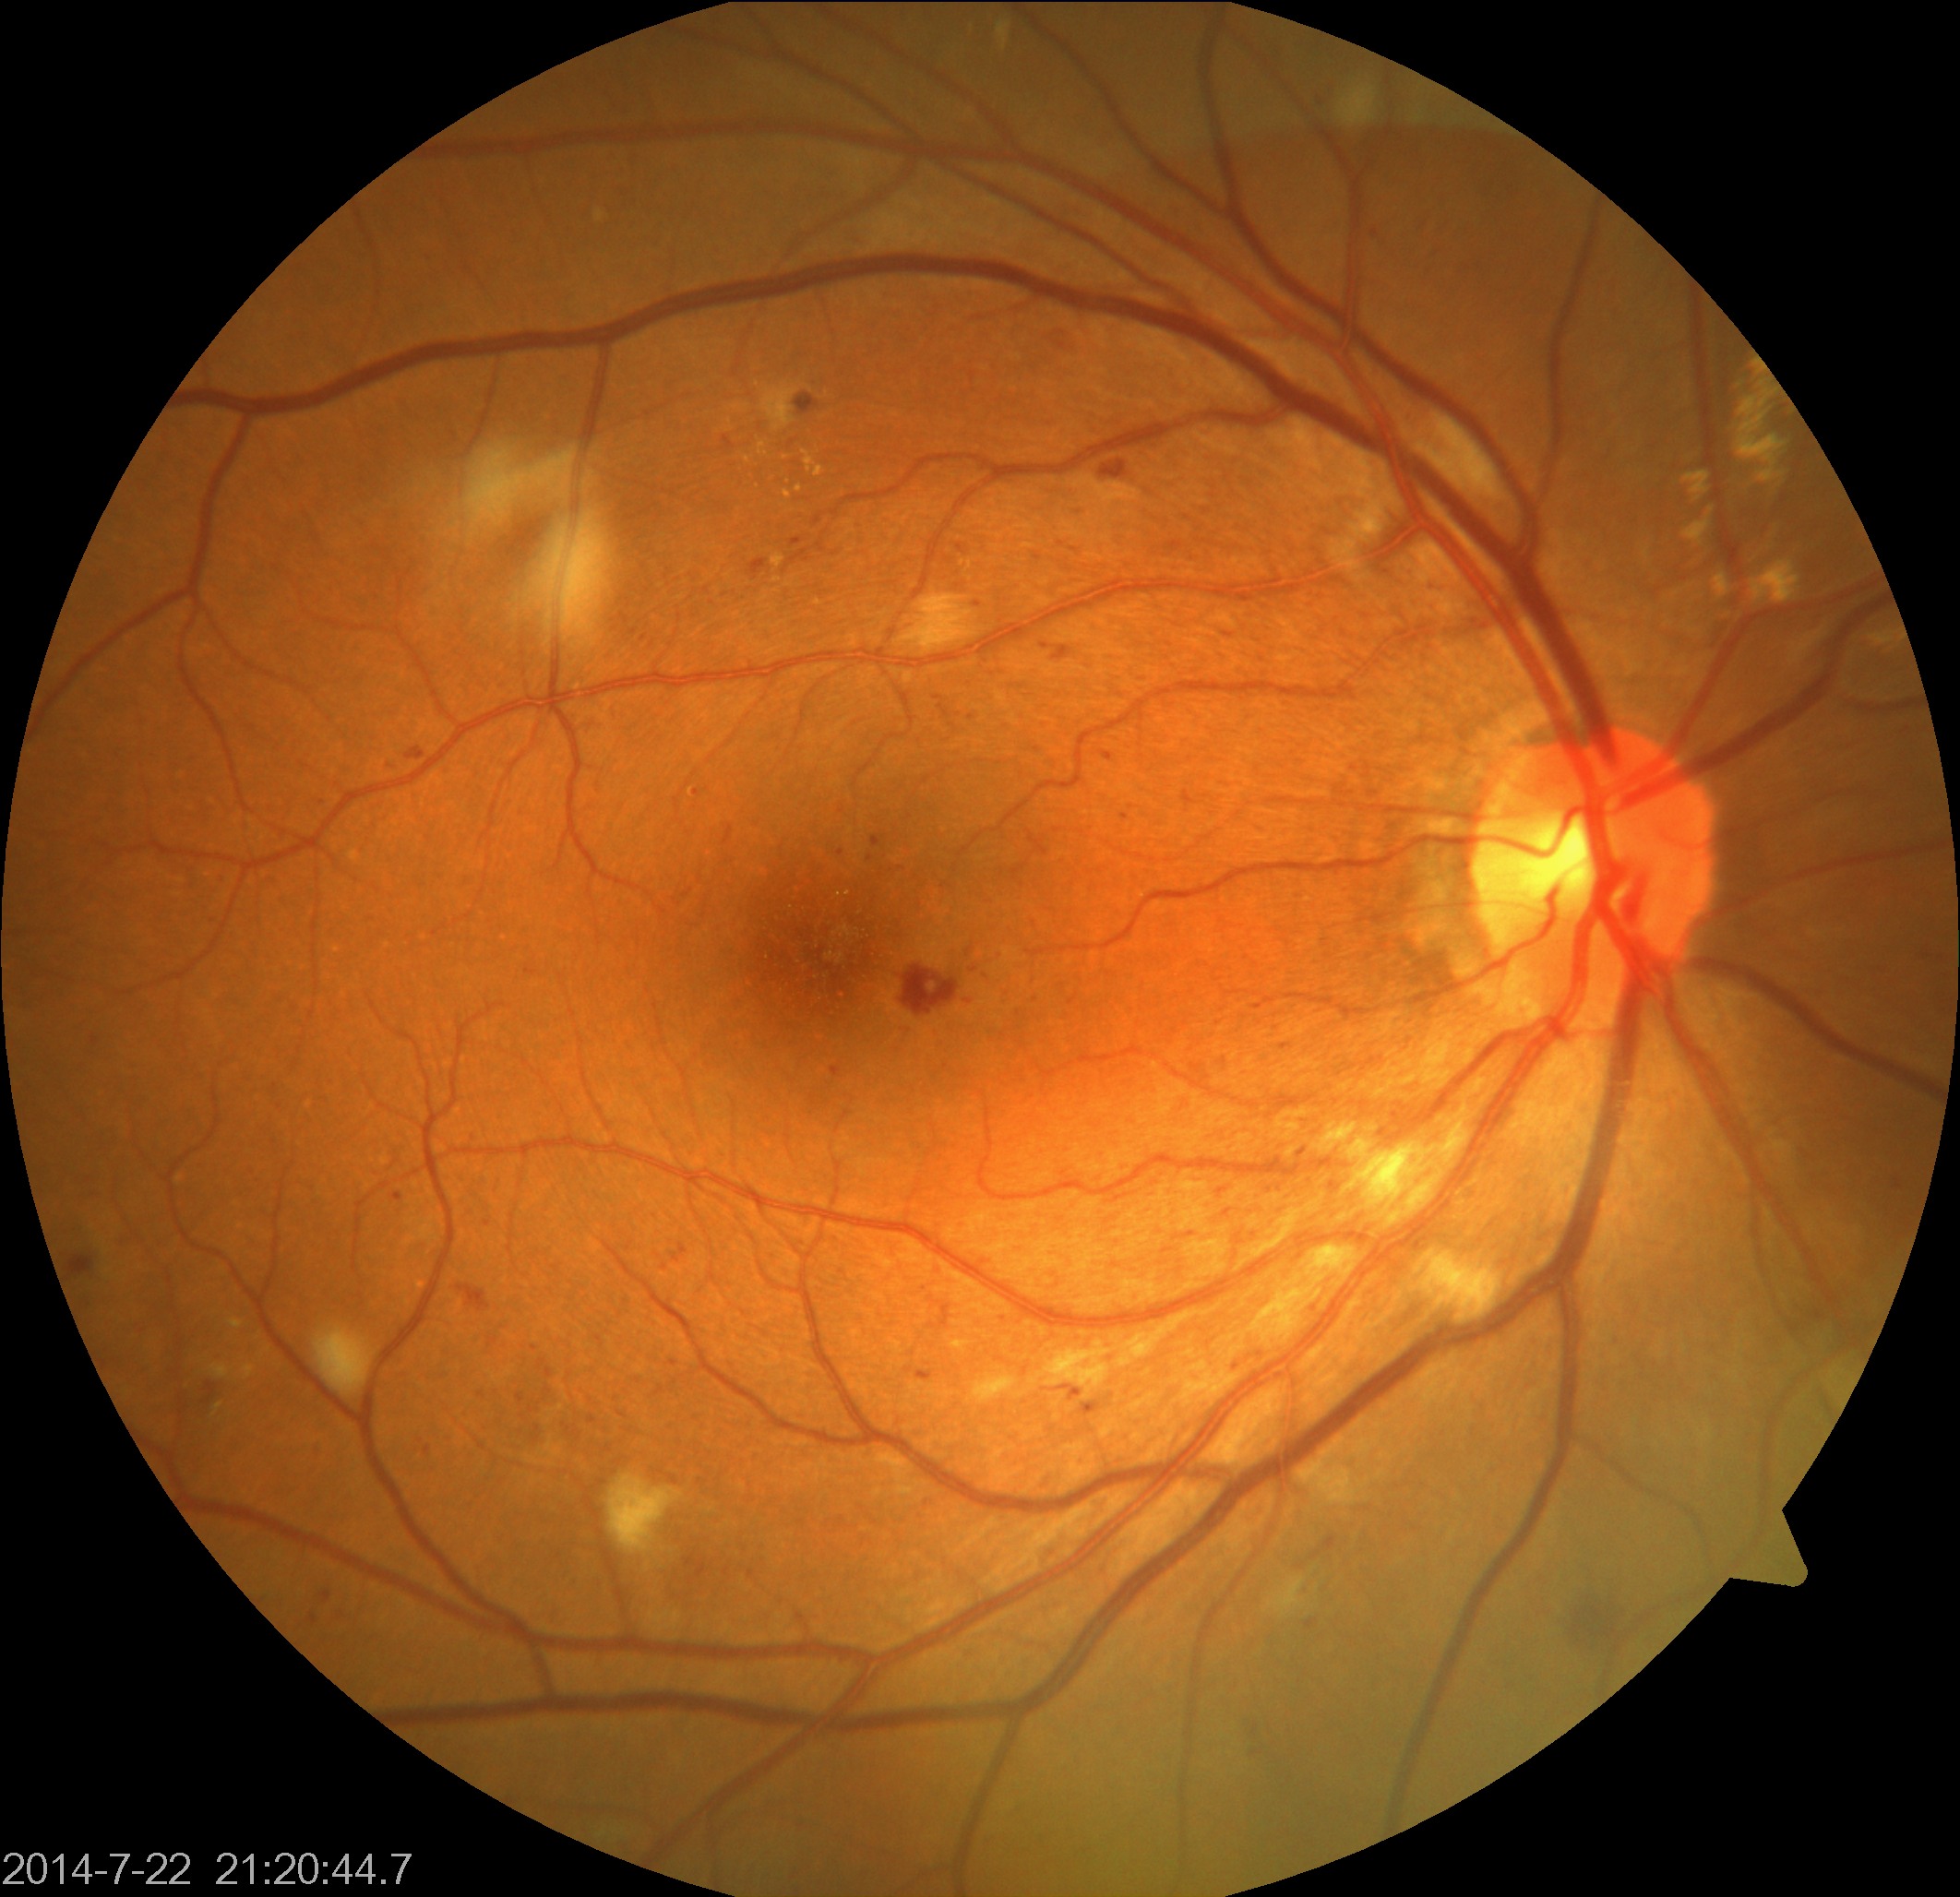
The image shows moderate non-proliferative diabetic retinopathy.